RetCam wide-field infant fundus image · 1440 x 1080 pixels:
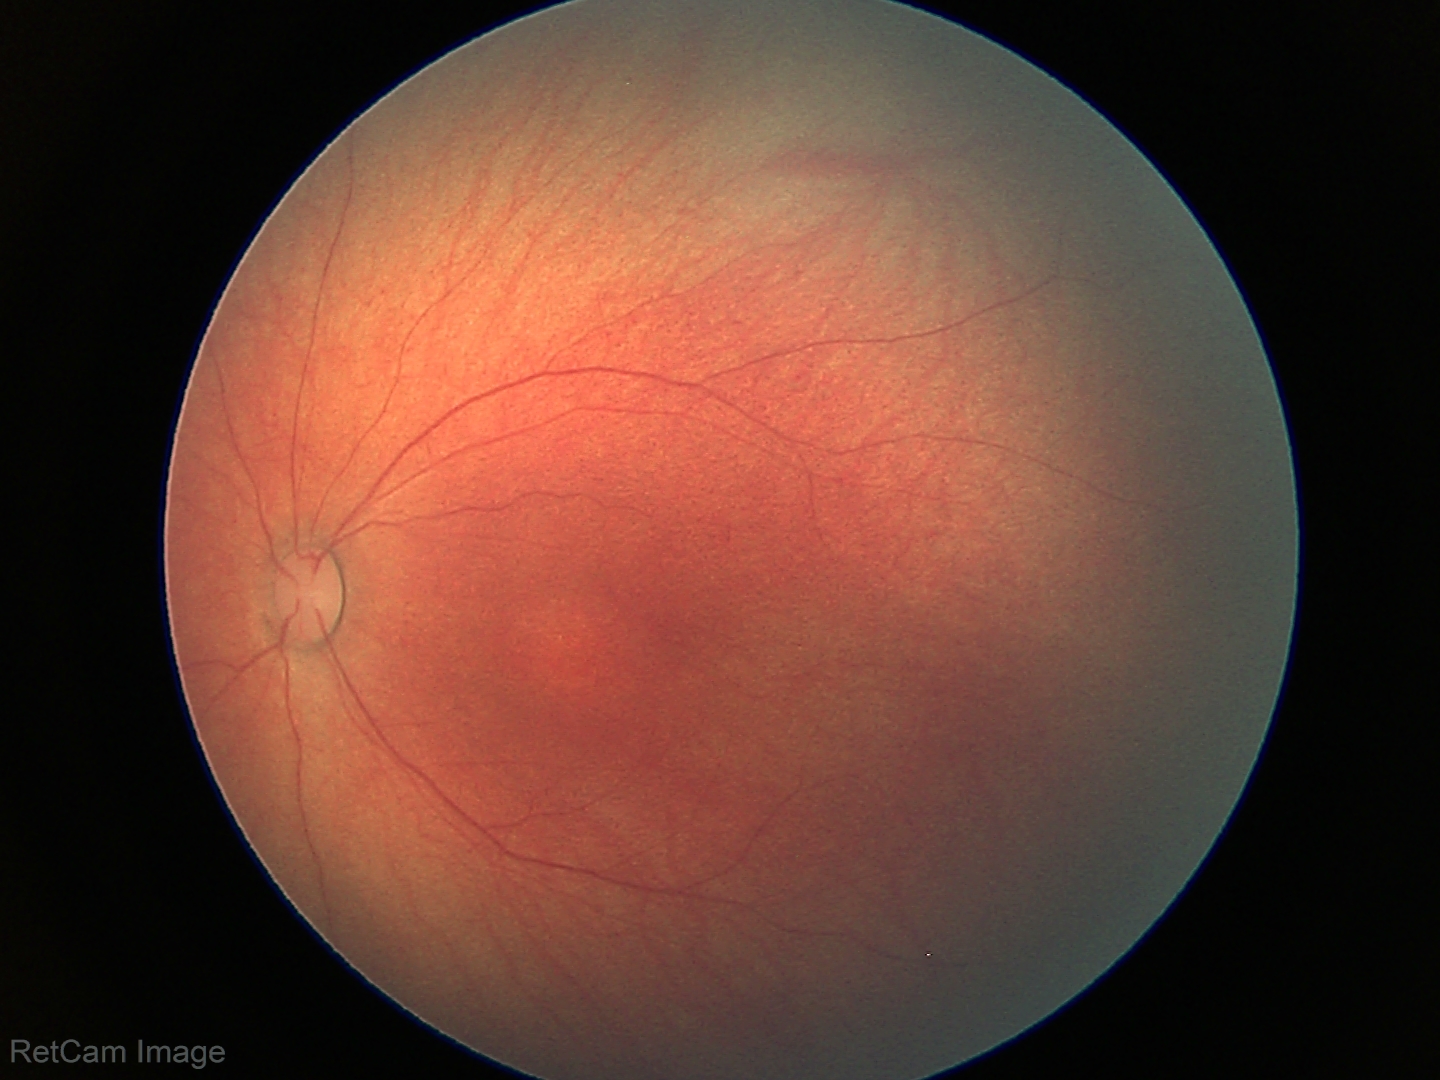

No retinal pathology identified on screening.